848 by 848 pixels:
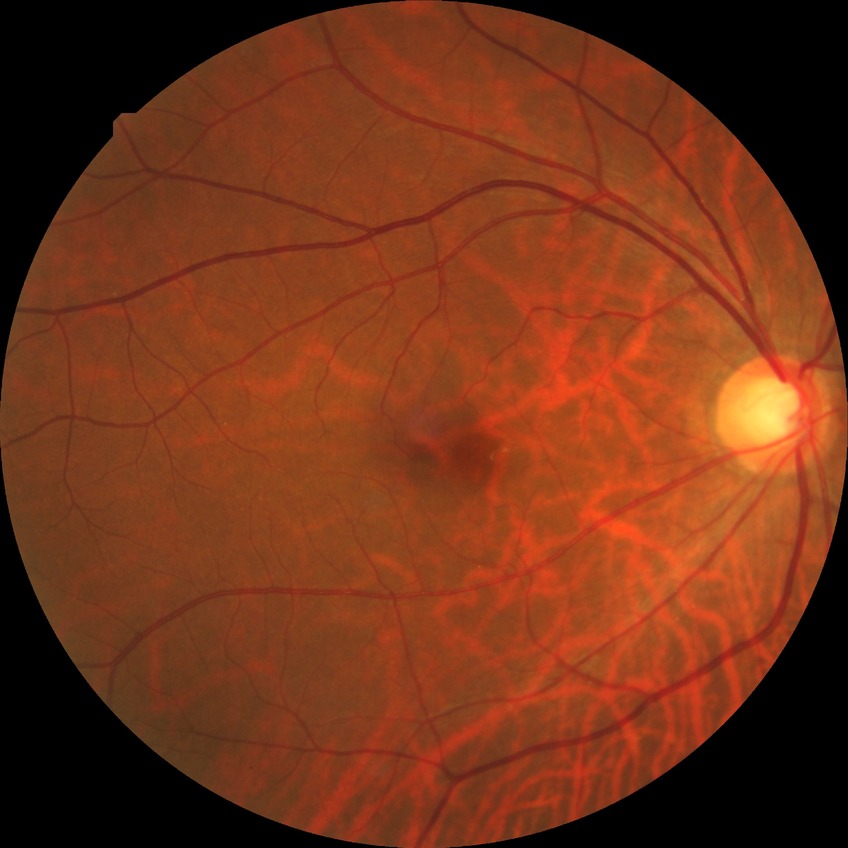
davis_grade: no diabetic retinopathy